Color fundus photograph.
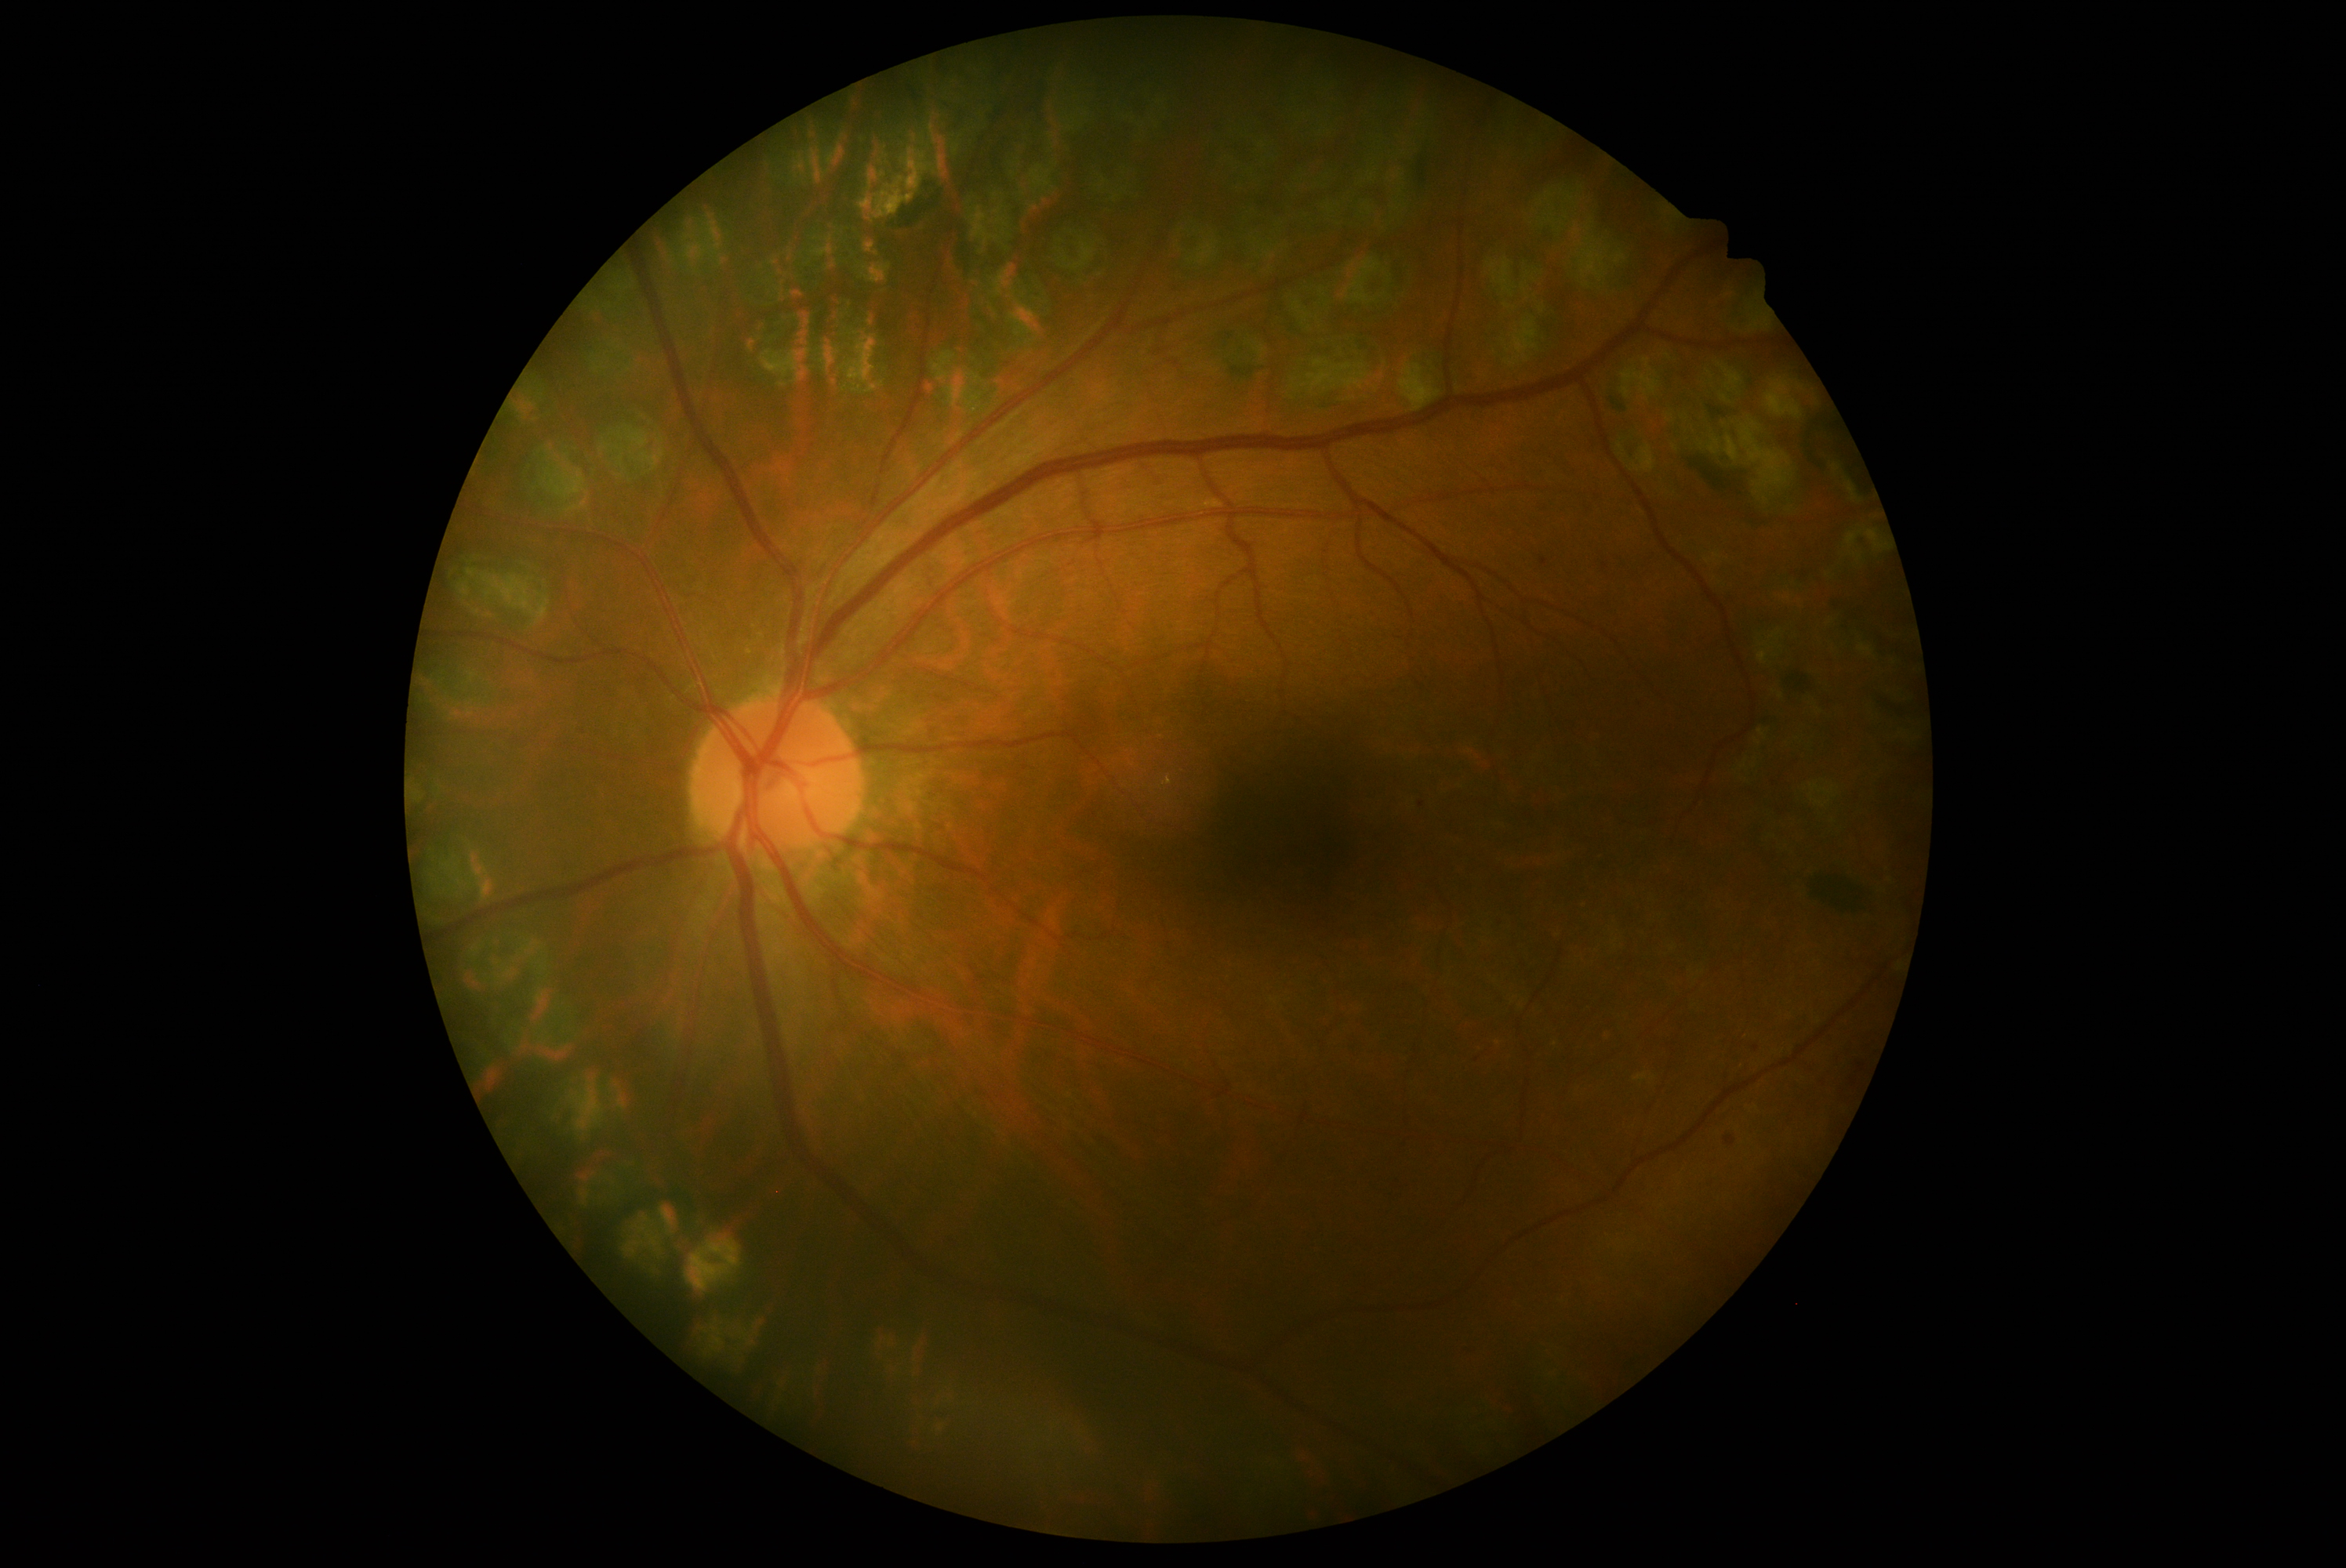 Diabetic retinopathy: 1/4.